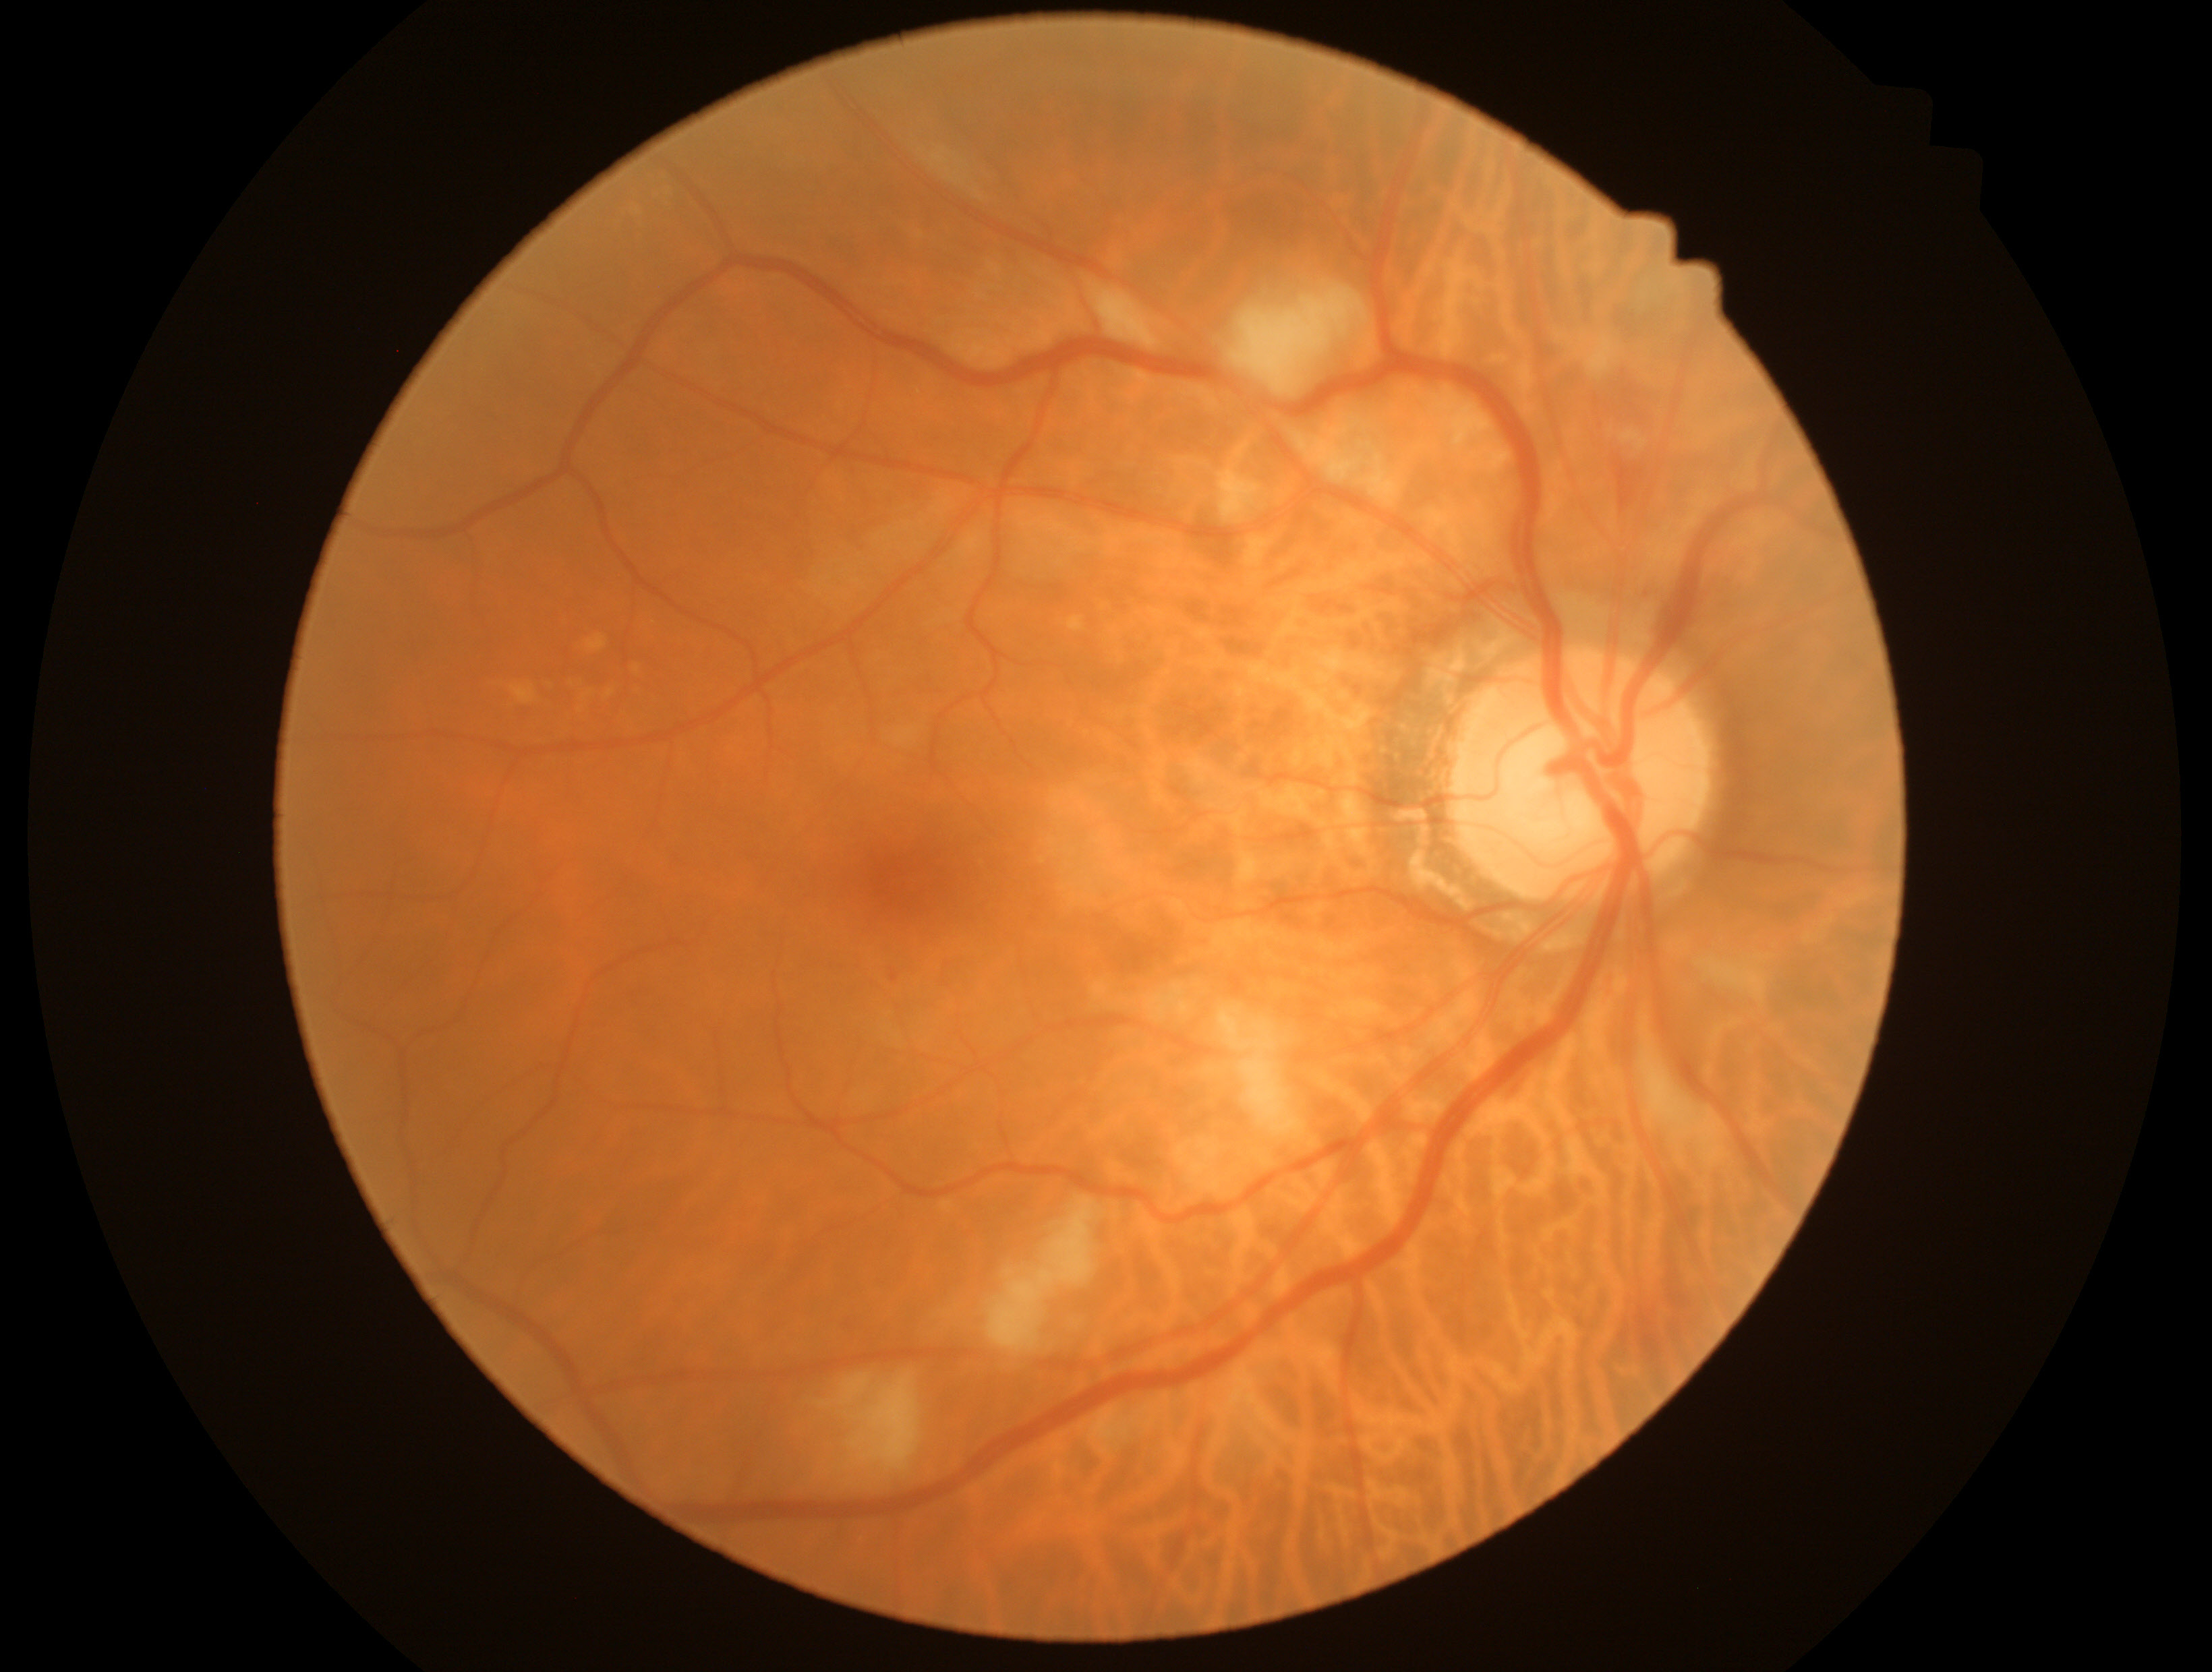

Annotations:
• diabetic retinopathy grade — 2
• DR class — non-proliferative diabetic retinopathy